Fundus photo; 45-degree field of view; 2352x1568px:
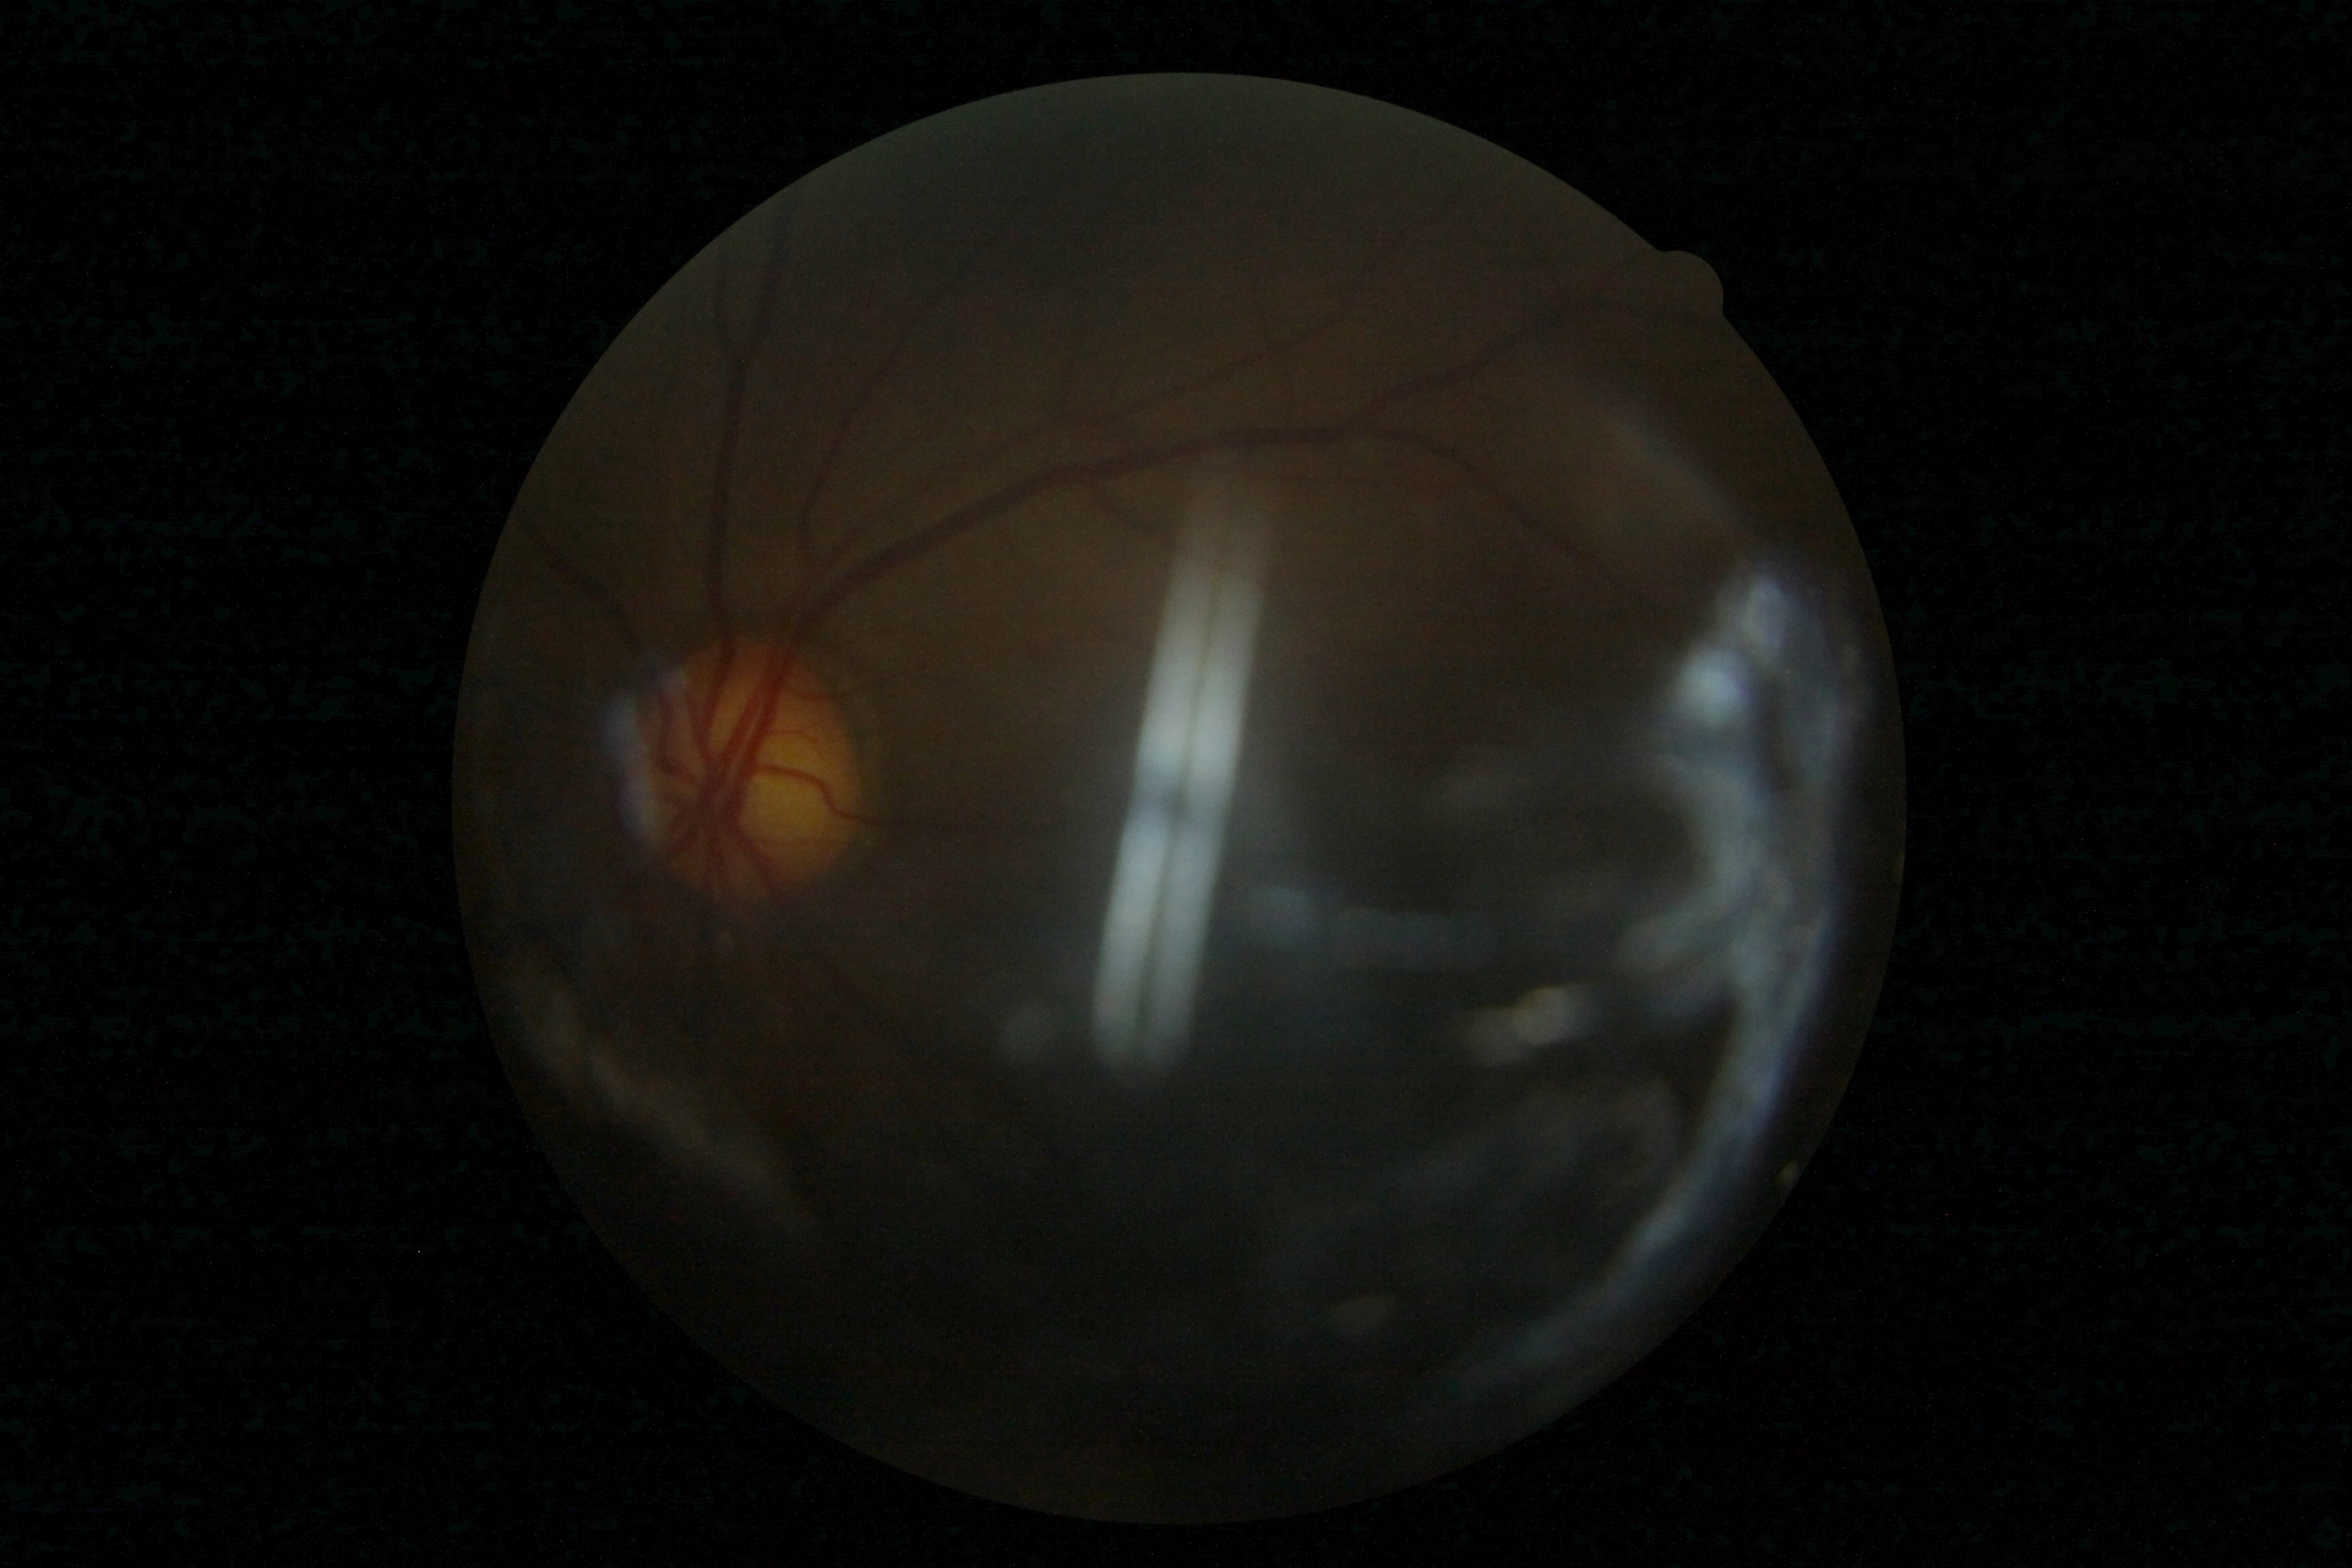

Ungradable image — DR severity cannot be determined.
Retinopathy is ungradable due to poor image quality.